50-degree field of view:
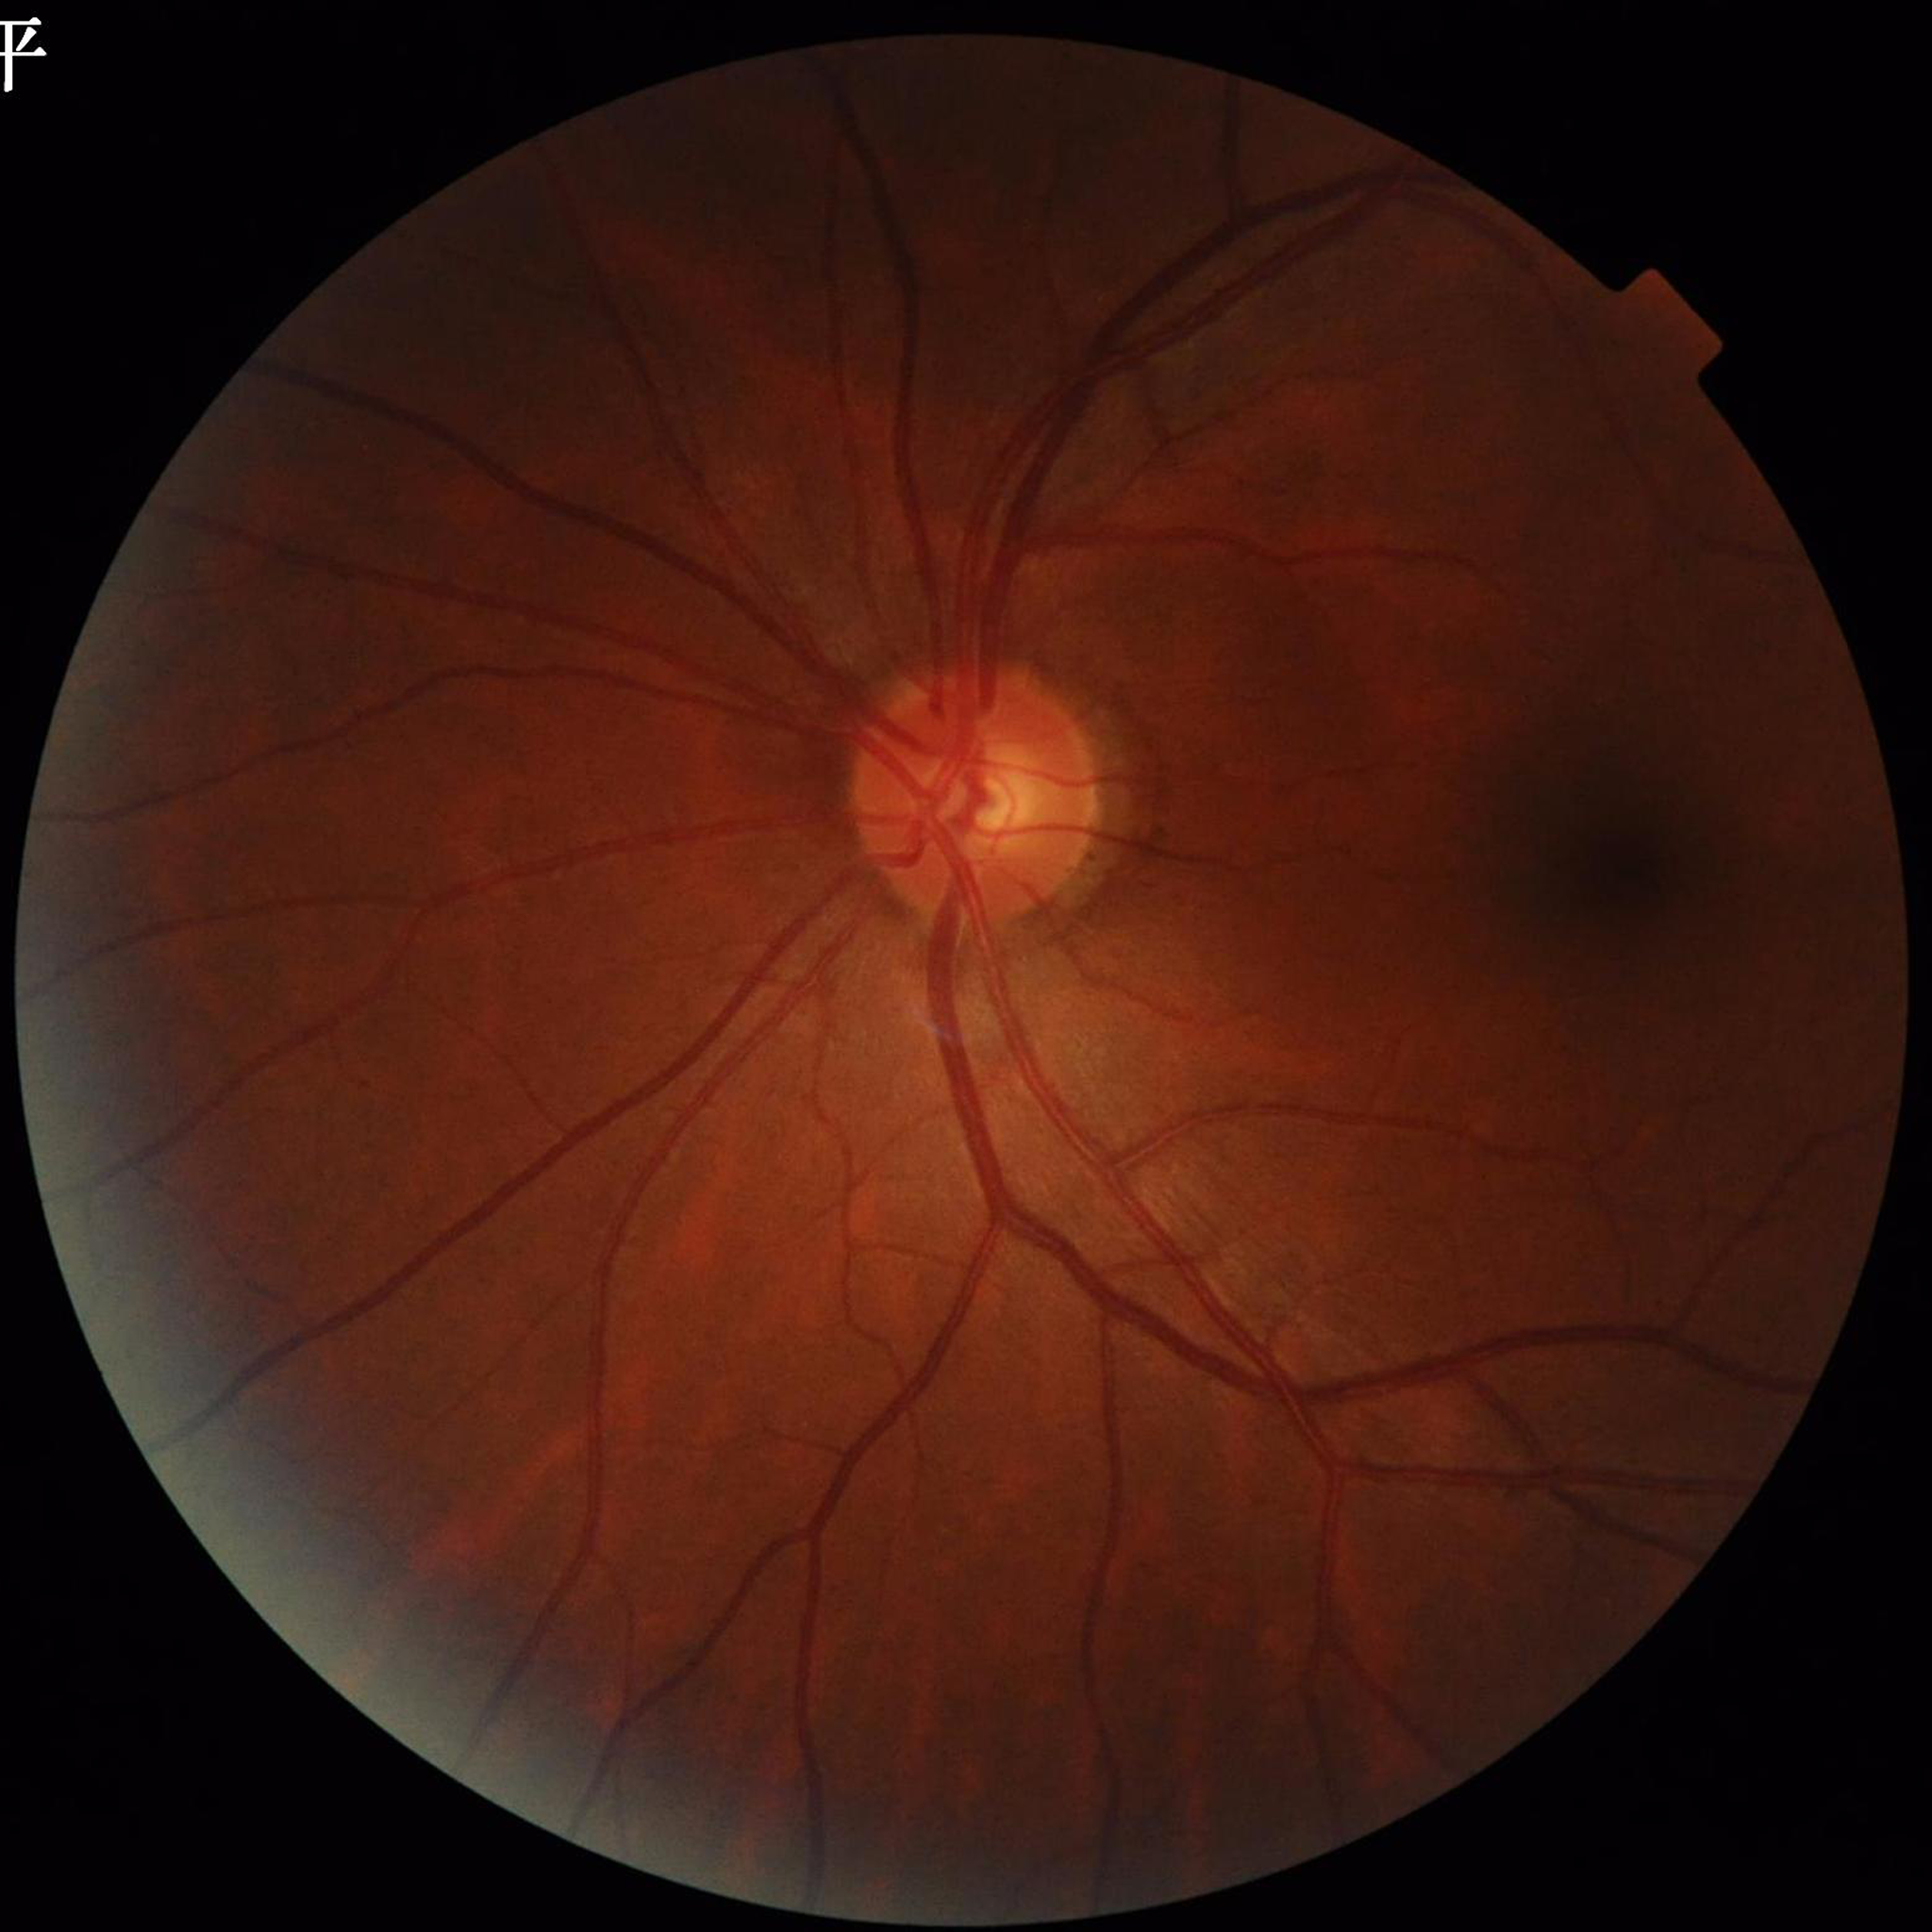
Color fundus photograph from a patient diagnosed with glaucoma. Photo quality: no blur, illumination and color satisfactory, contrast adequate.